Nidek AFC-330; centered on the optic disc — 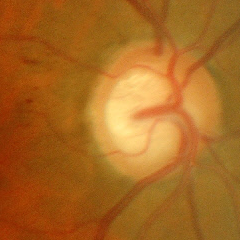

Early glaucomatous optic neuropathy.